2352 by 1568 pixels; color fundus photograph — 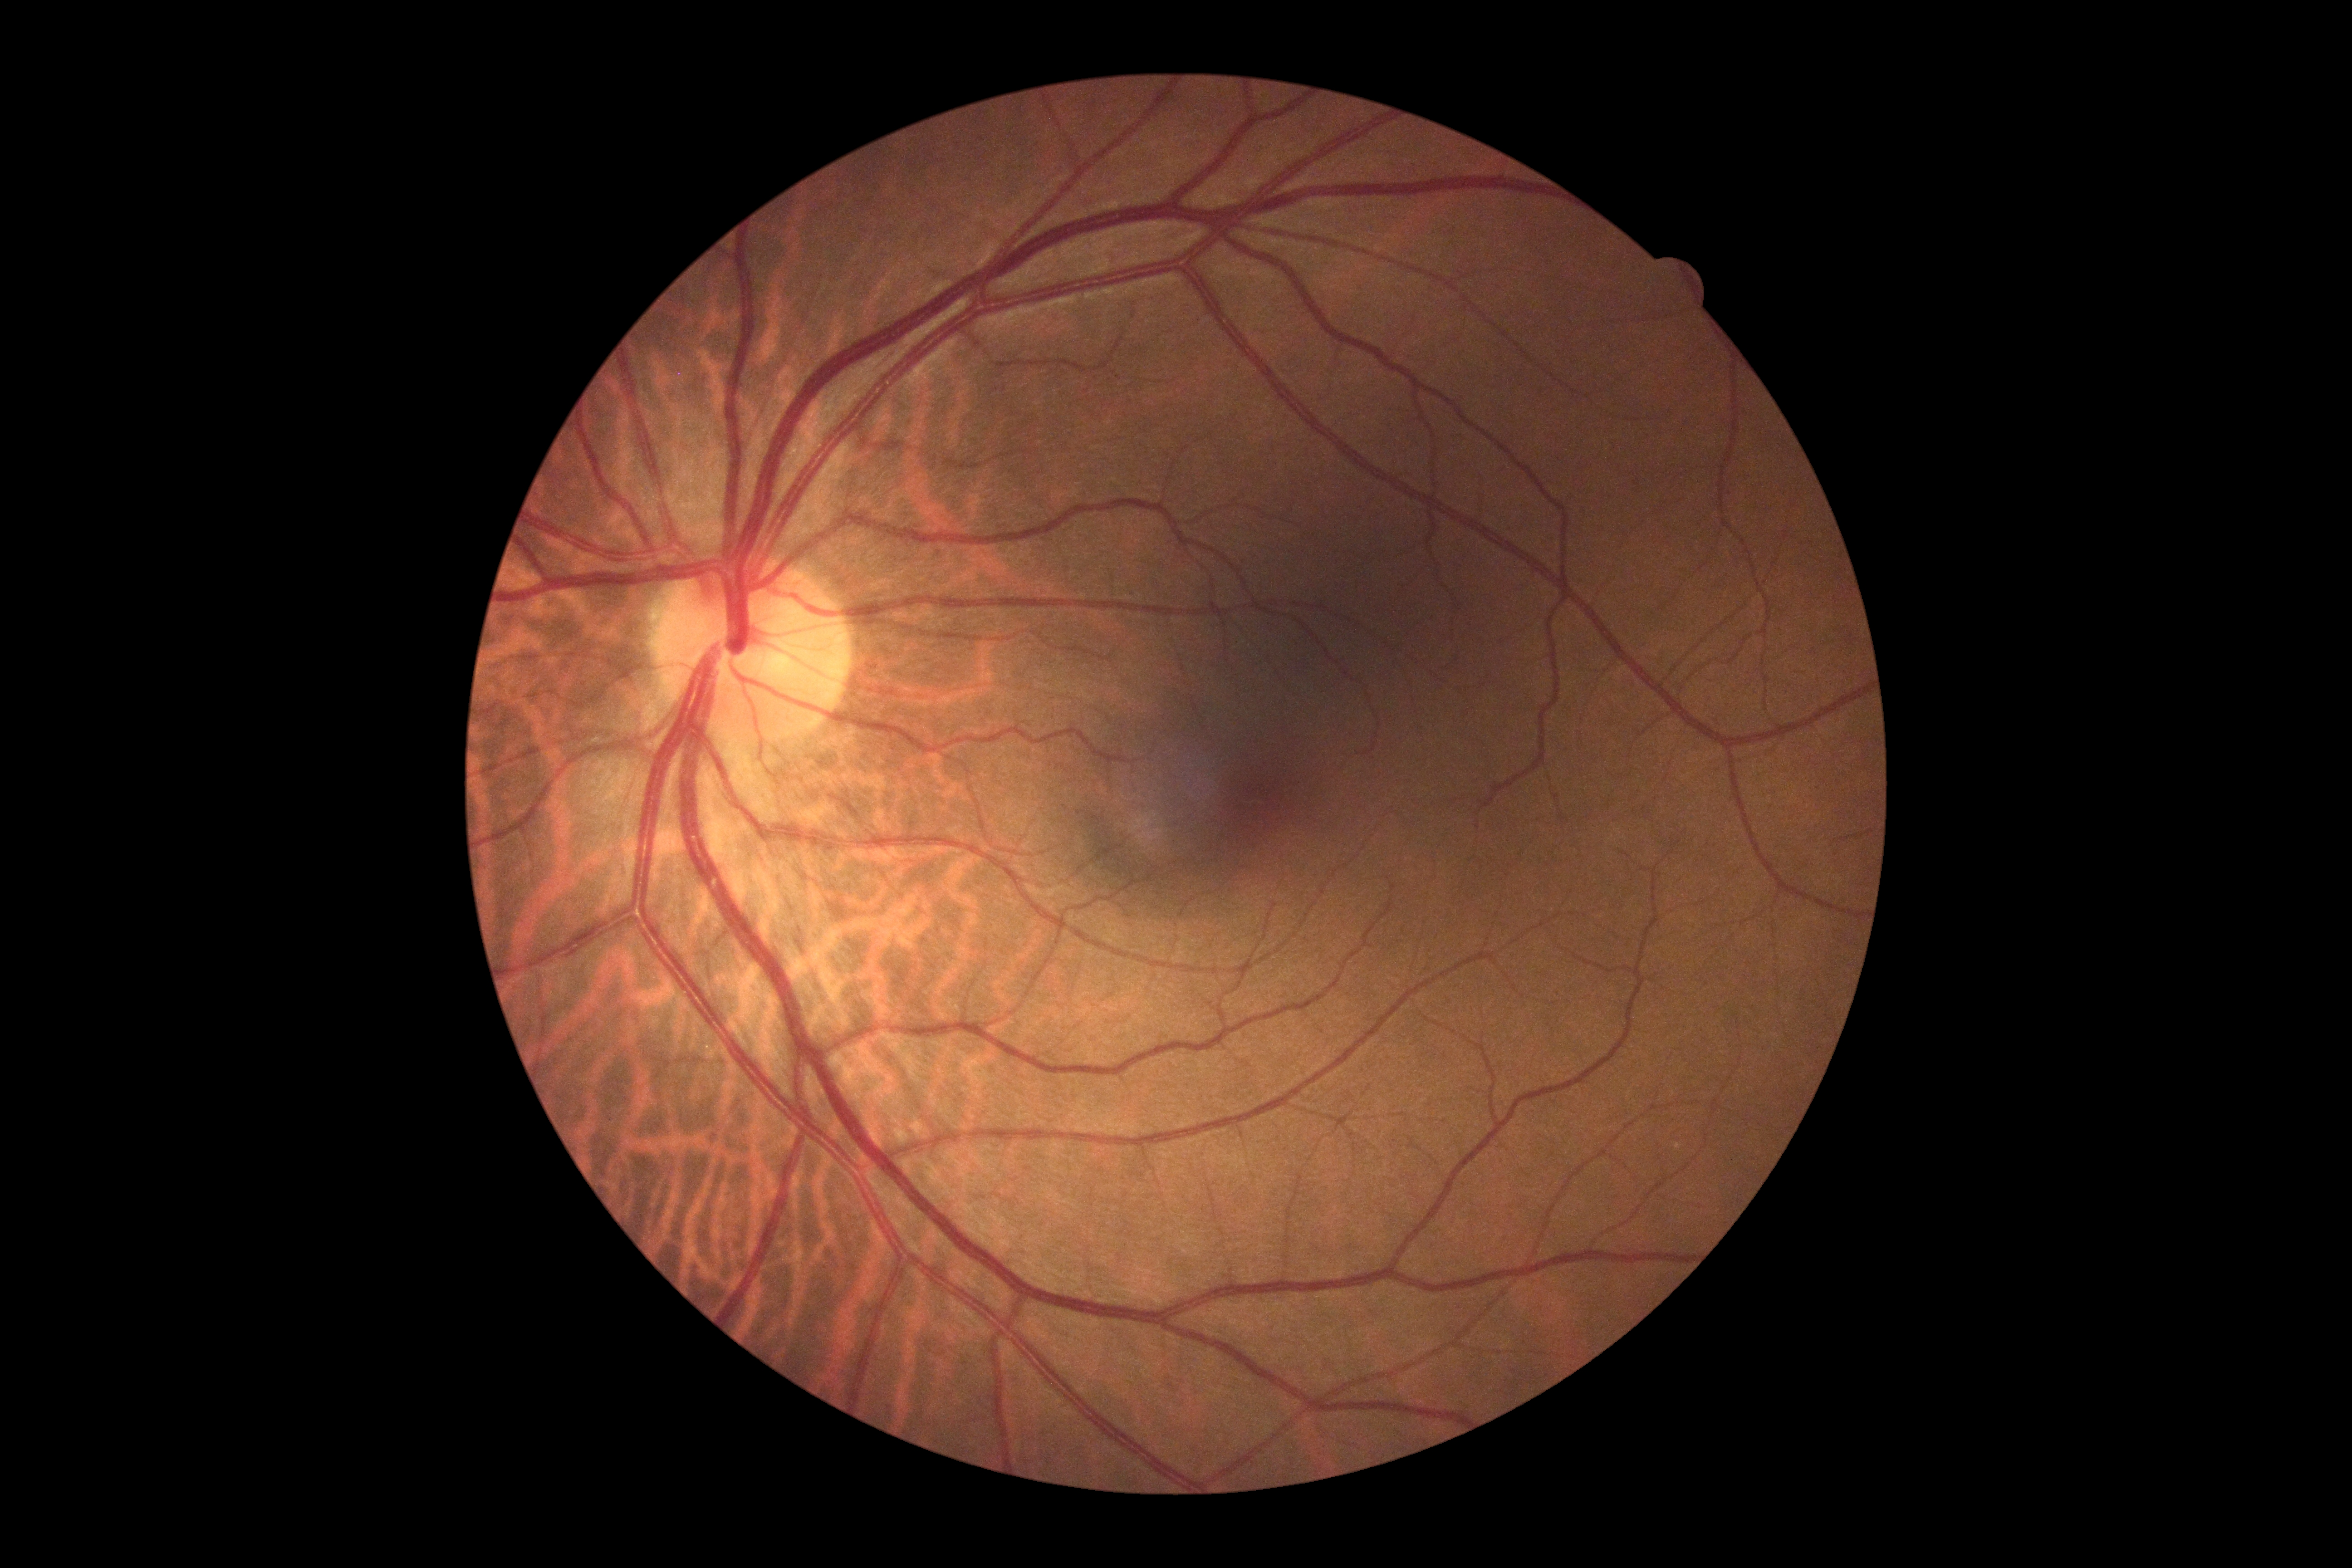
DR impression: no apparent DR; DR: 0/4.